Without pupil dilation, NIDEK AFC-230 fundus camera, 848x848: 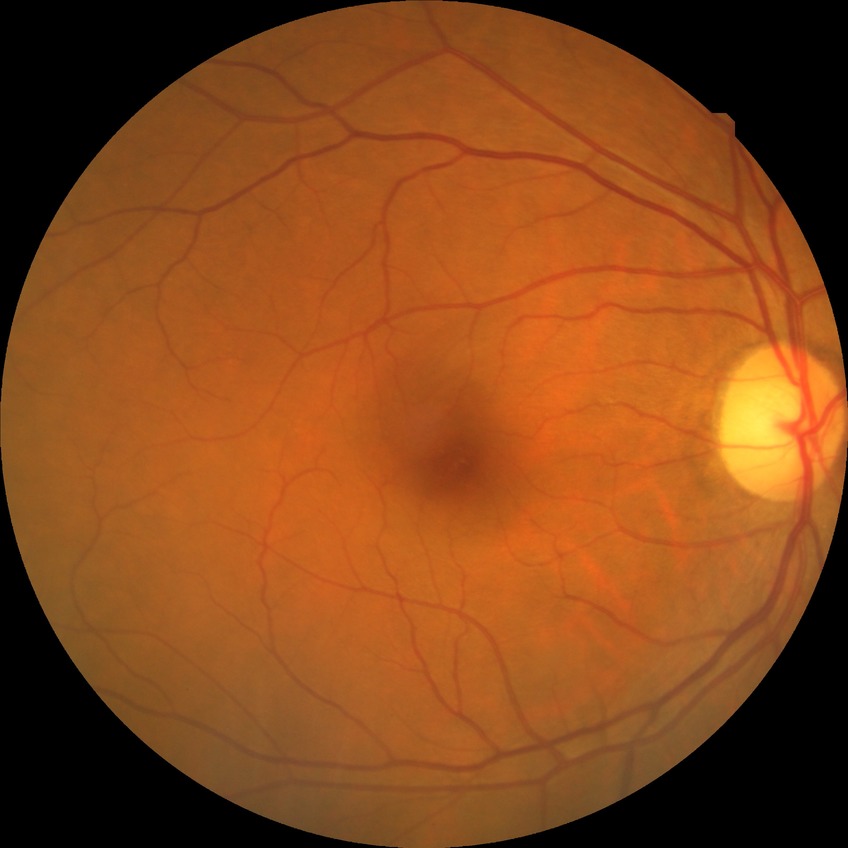

Diabetic retinopathy (DR): NDR (no diabetic retinopathy).